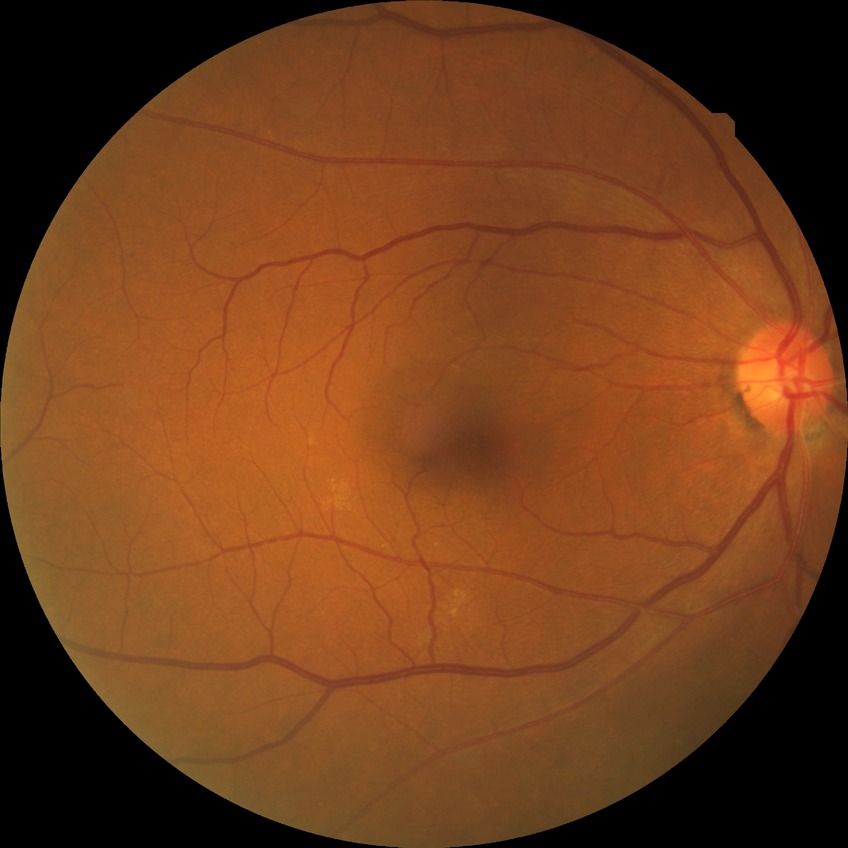 Modified Davis grading: no diabetic retinopathy.